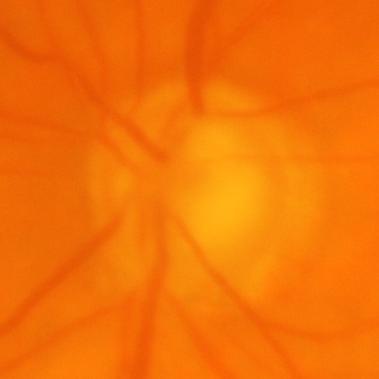 Diagnosis = glaucomatous optic neuropathy.